No pharmacologic dilation, 45-degree field of view, 848 by 848 pixels — 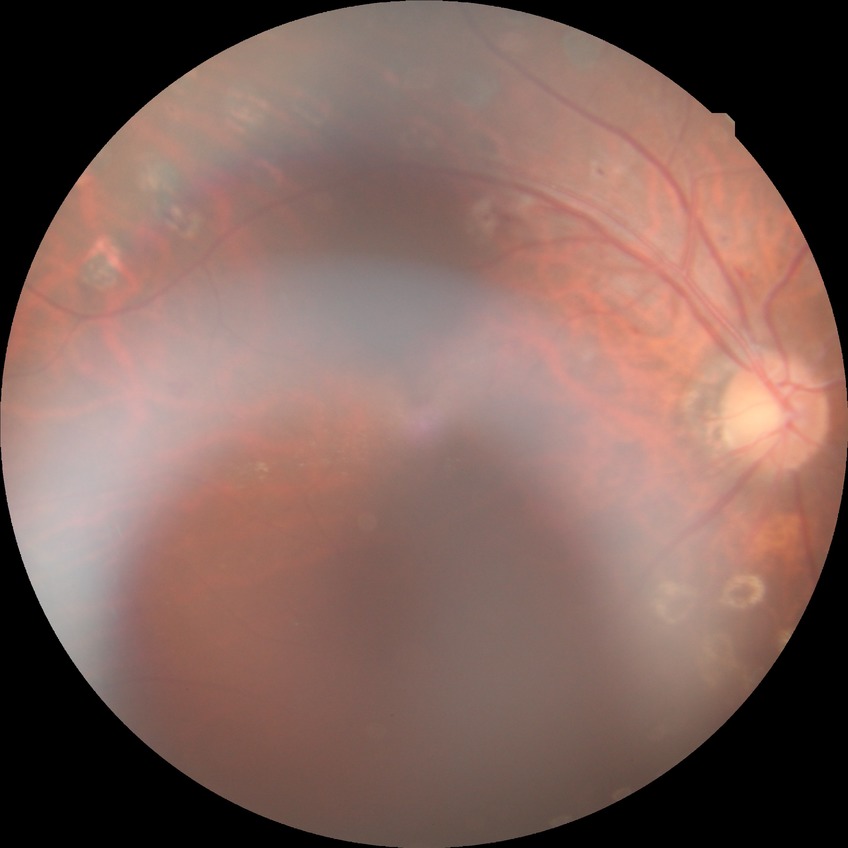

- diabetic retinopathy (DR) — proliferative diabetic retinopathy (PDR)